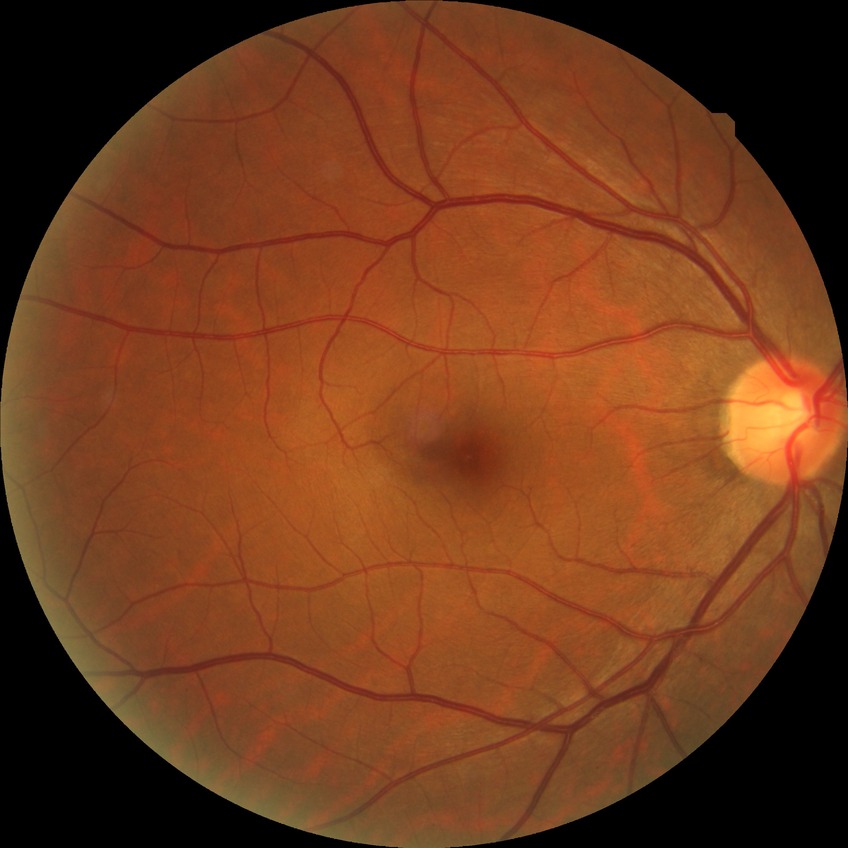
diabetic retinopathy (DR): NDR (no diabetic retinopathy).